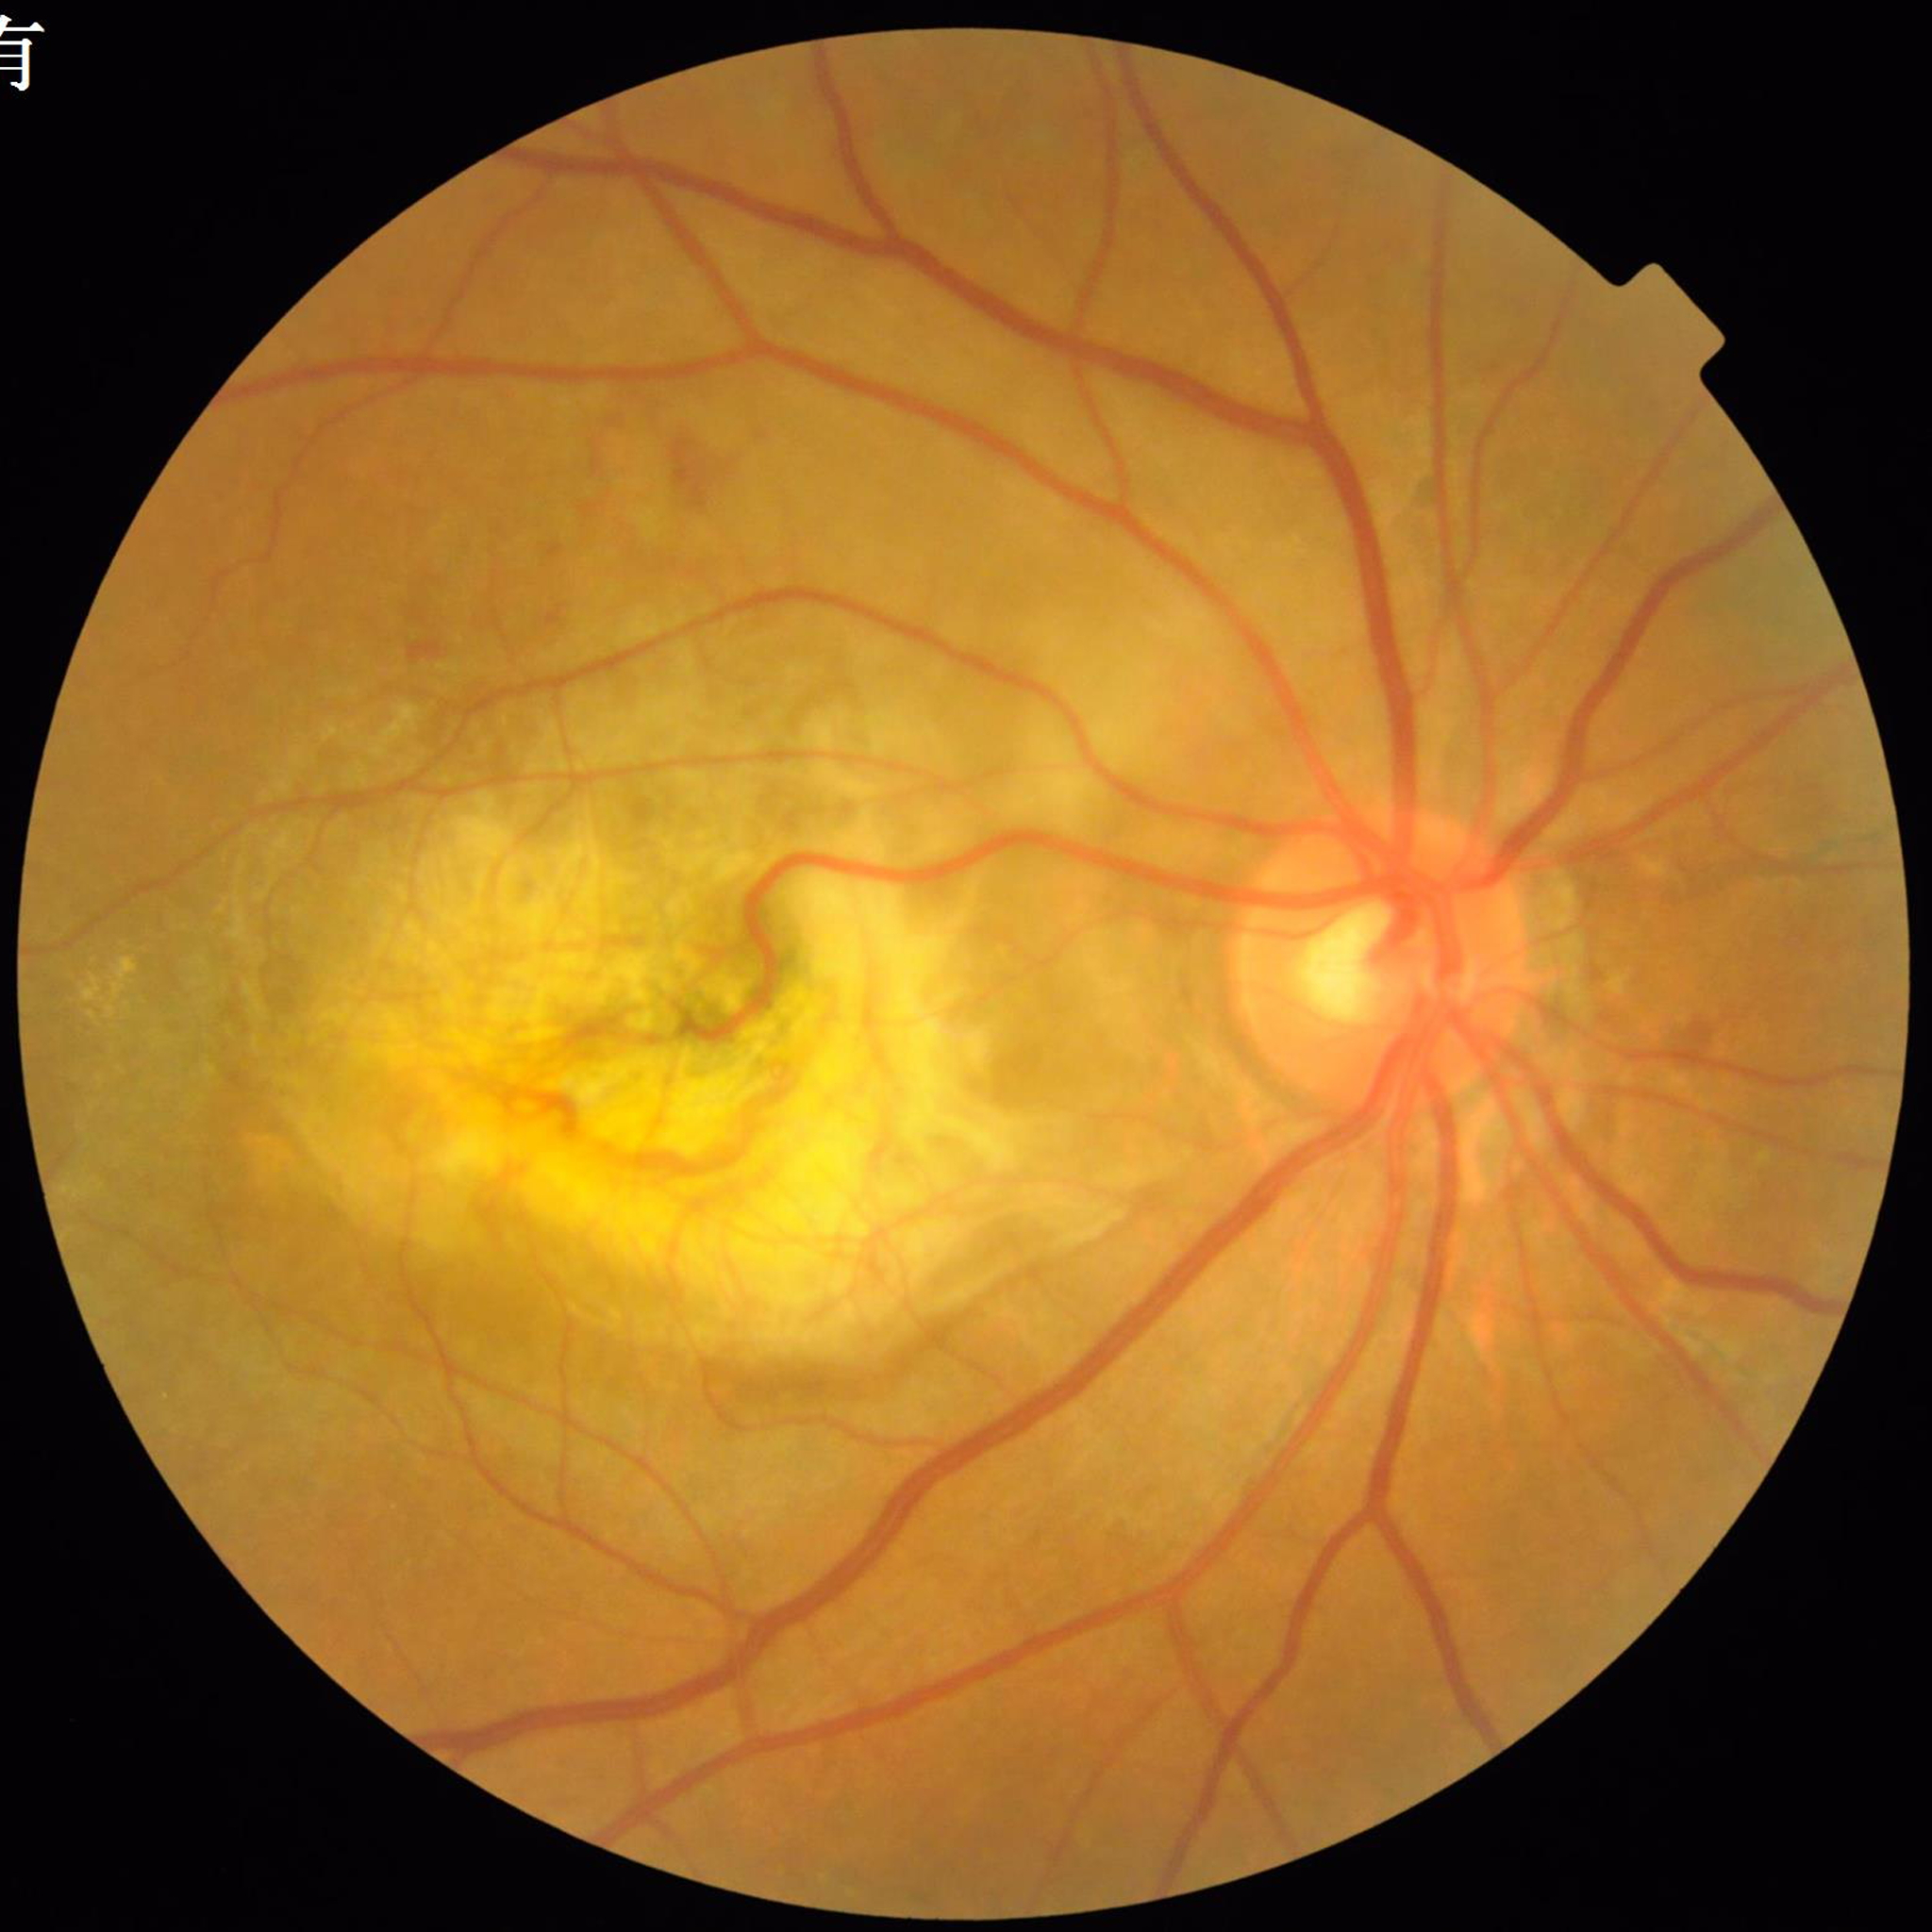

This fundus photograph is from a patient diagnosed with AMD.